2368x1568px.
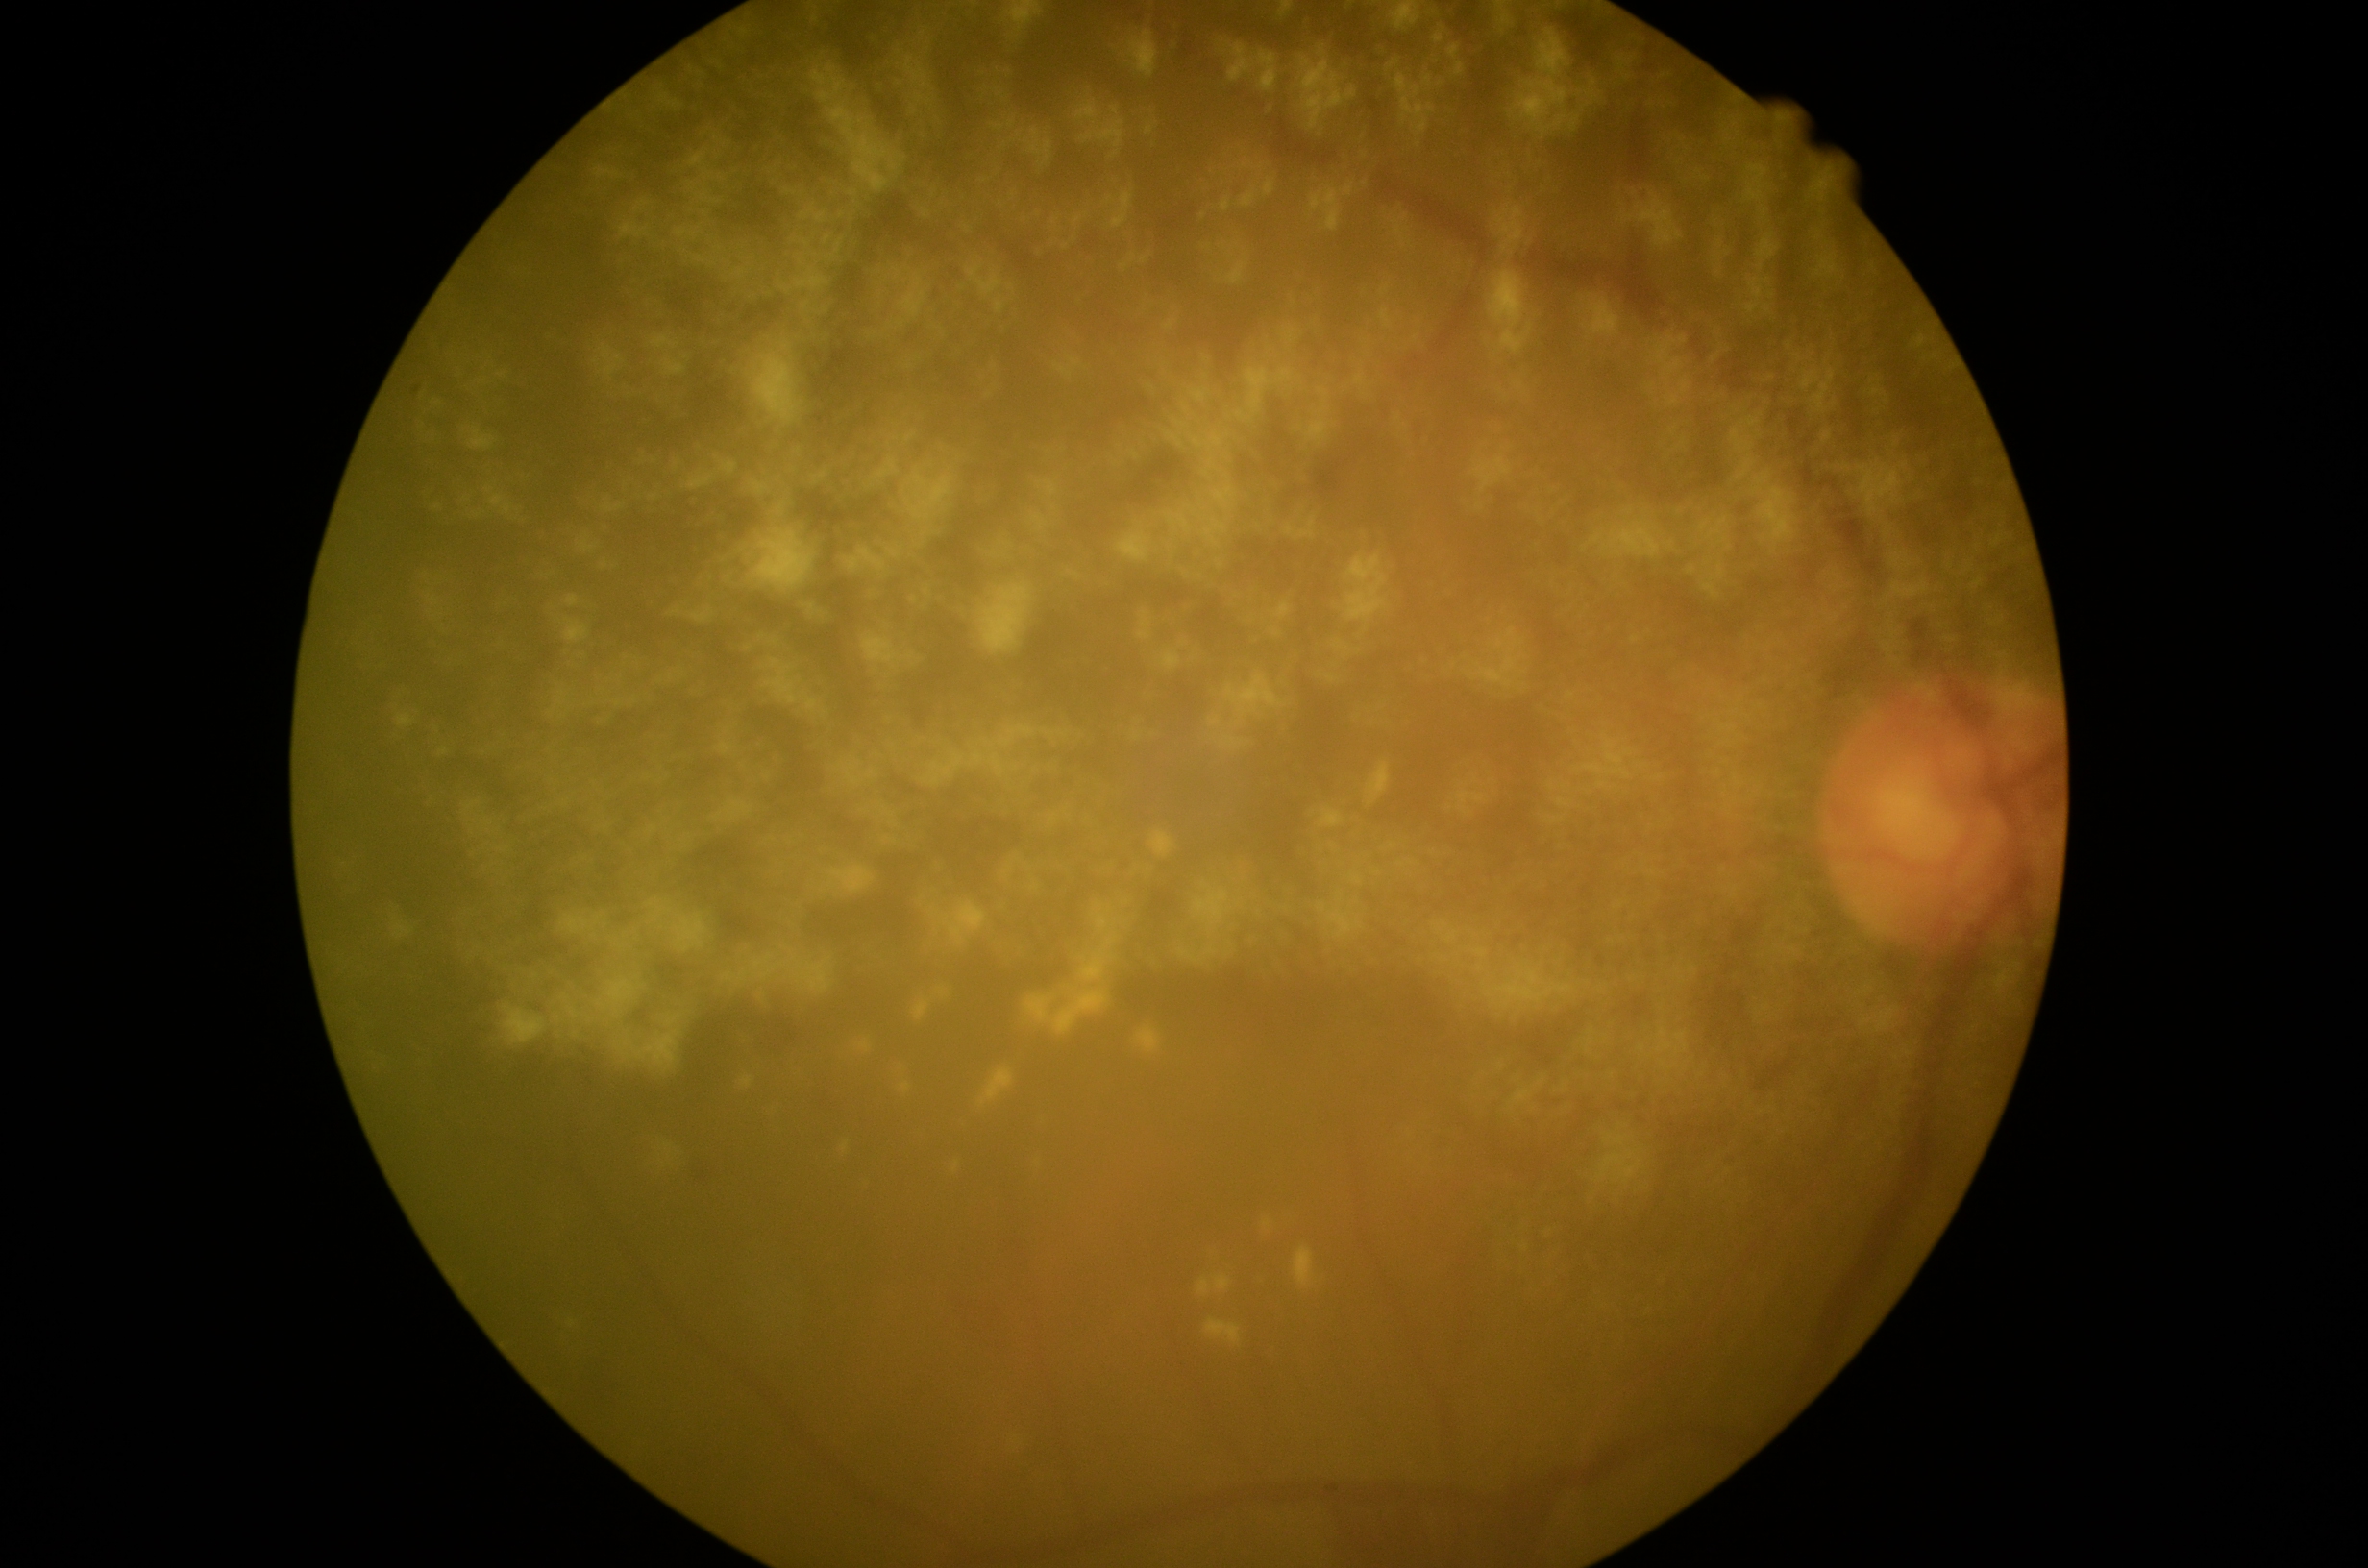
– retinopathy grade — moderate non-proliferative diabetic retinopathy (2)